Acquired with a NIDEK AFC-230, without pupil dilation — 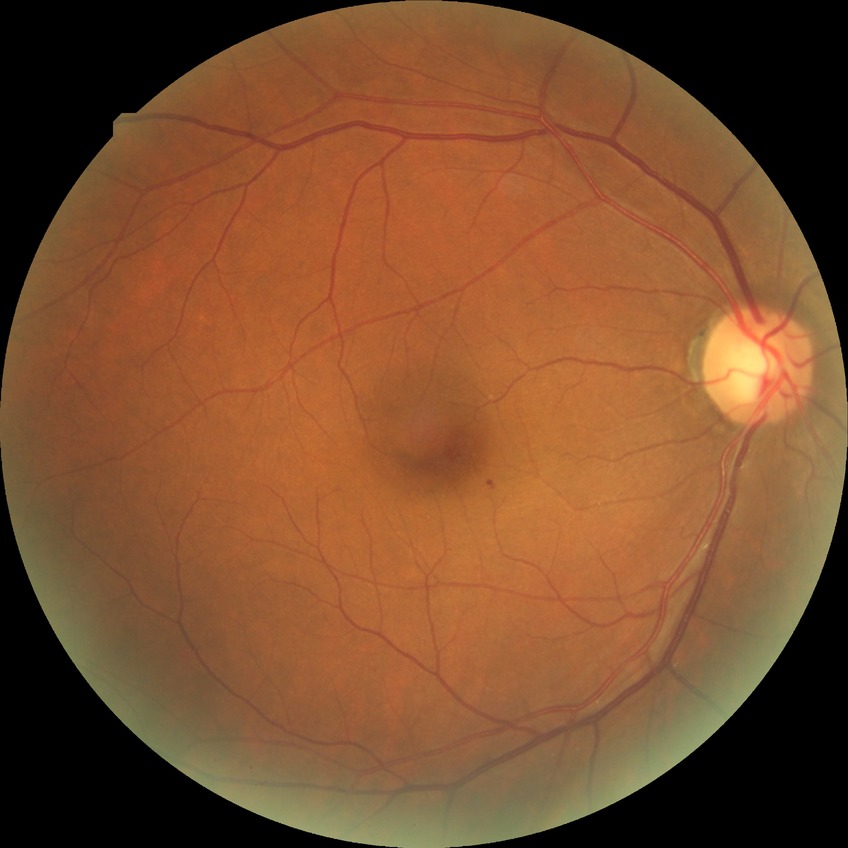 Diabetic retinopathy (DR) is no diabetic retinopathy (NDR).